Handheld portable fundus camera image: 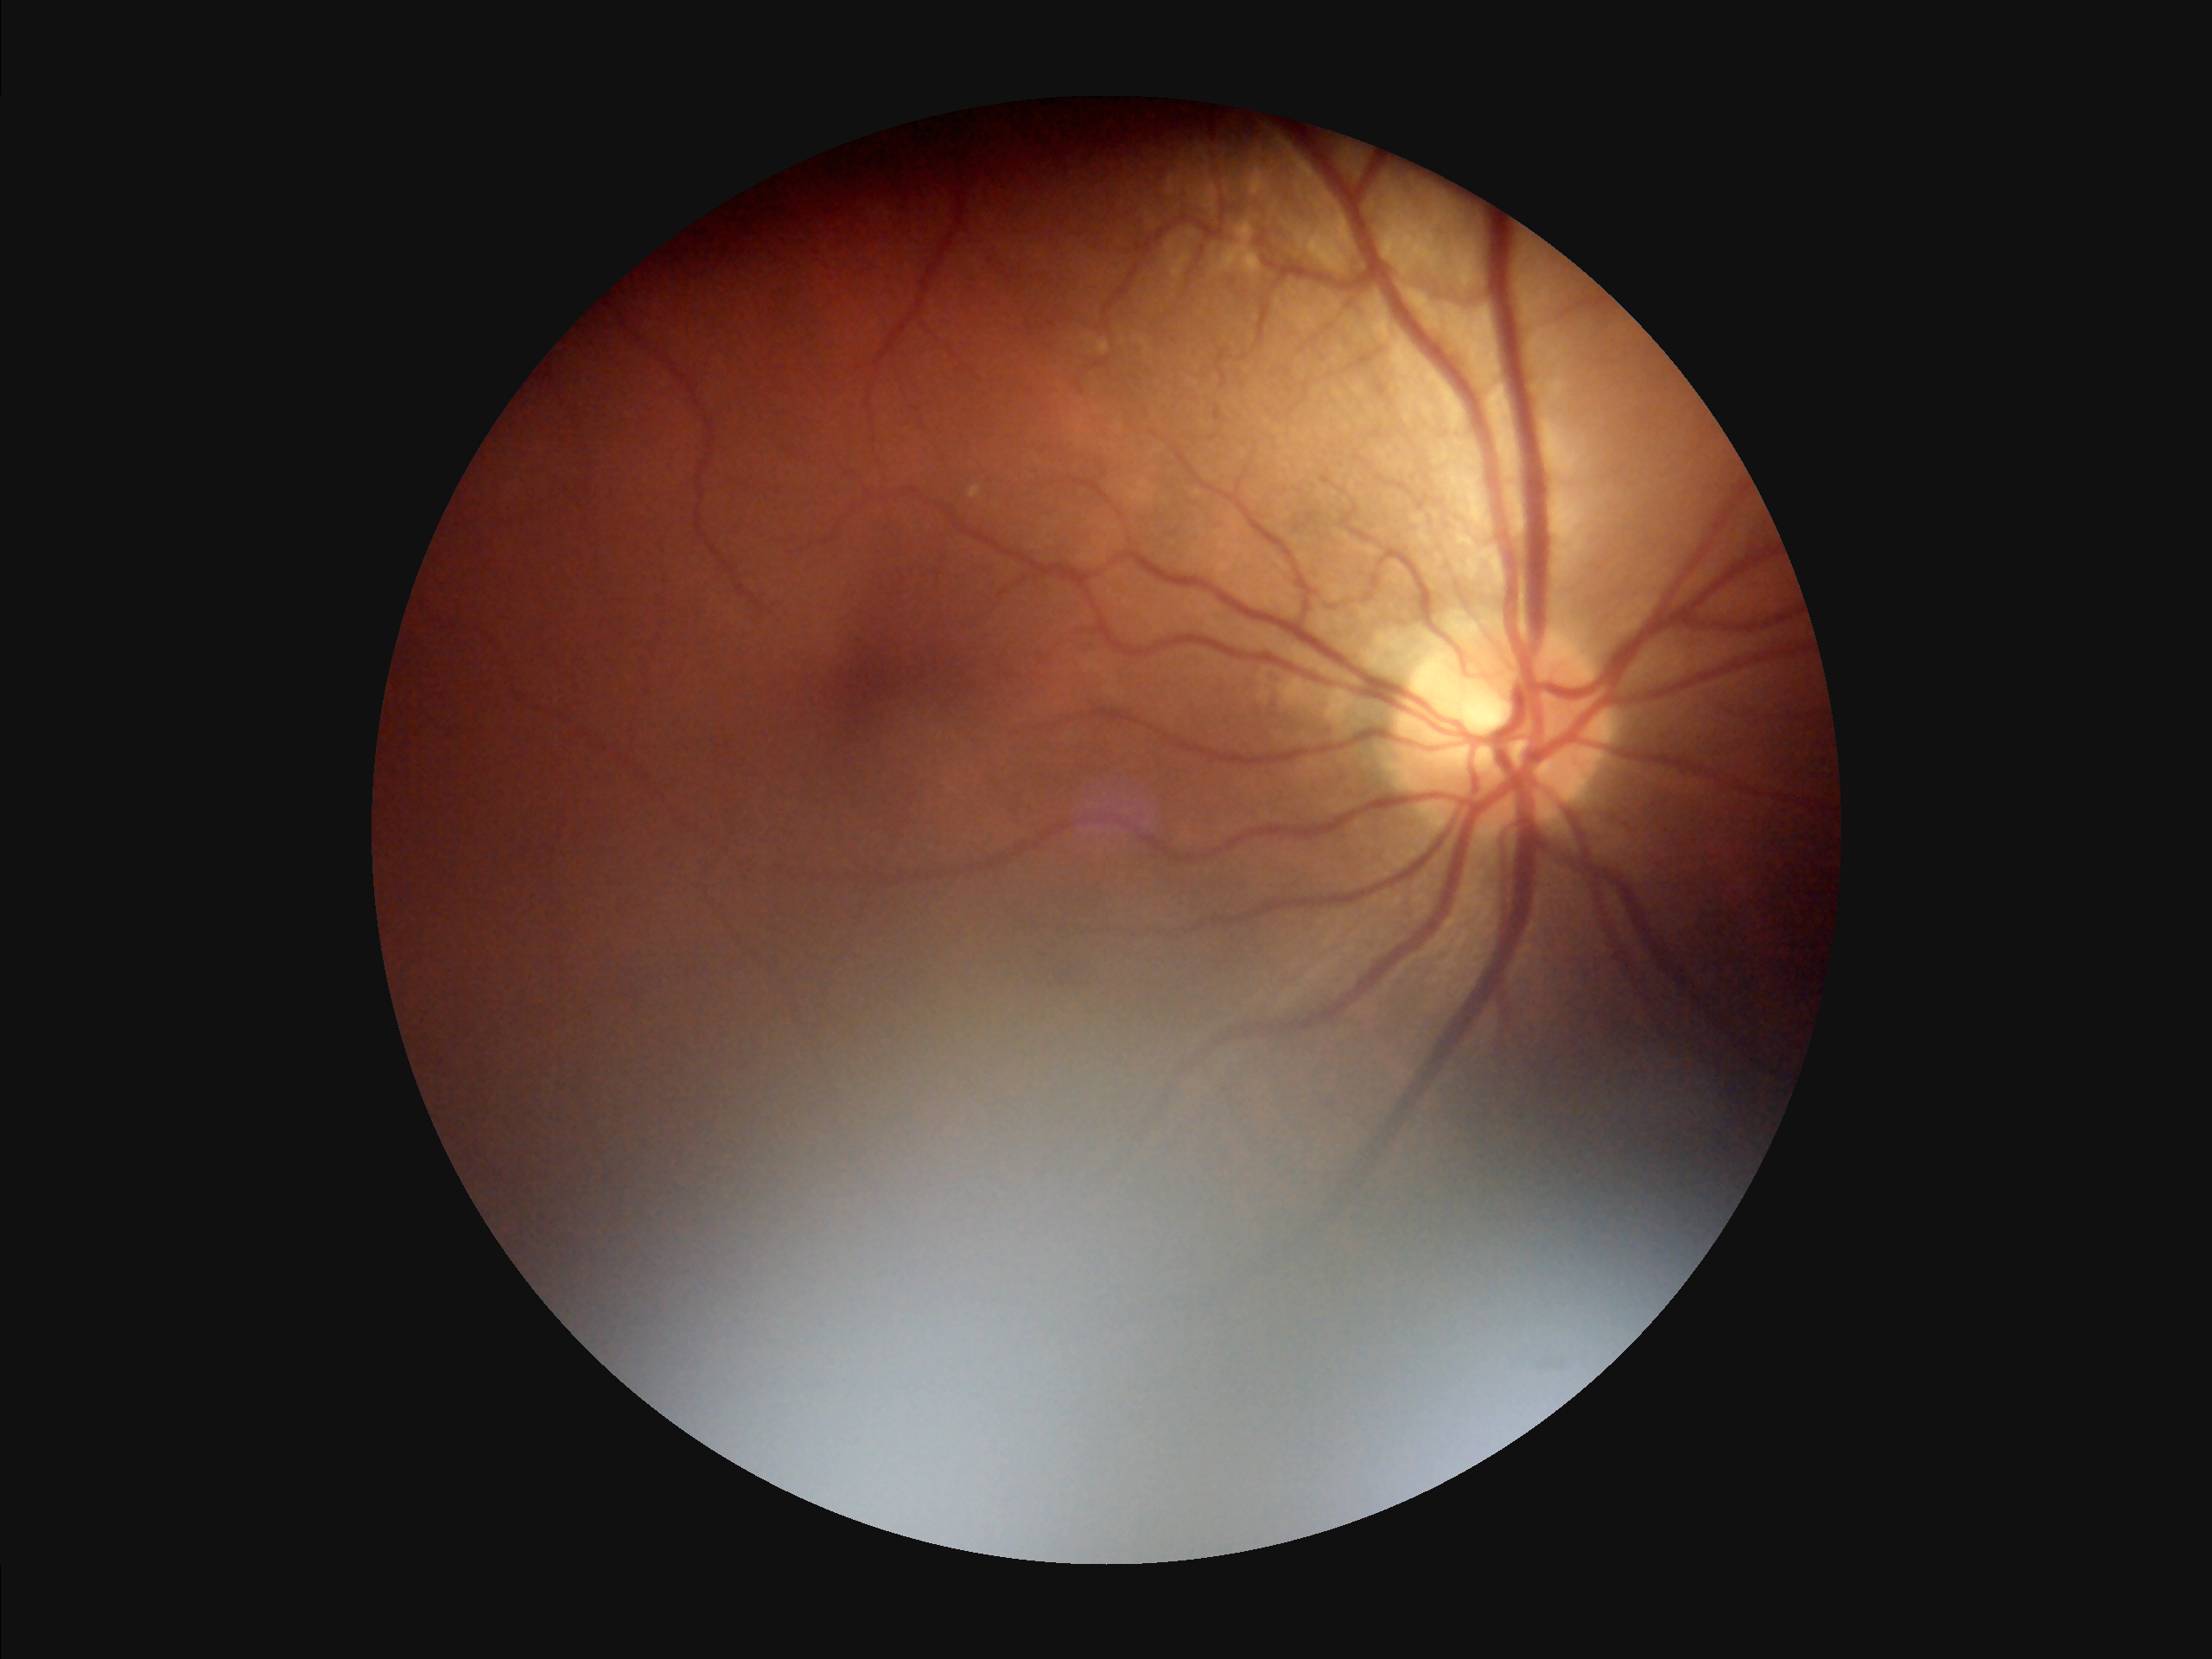 Overall = inadequate for clinical interpretation
Illumination/color = inadequate, with uneven exposure or color distortion
Contrast = vessels and details readily distinguishable
Focus = reduced sharpness with visible blur